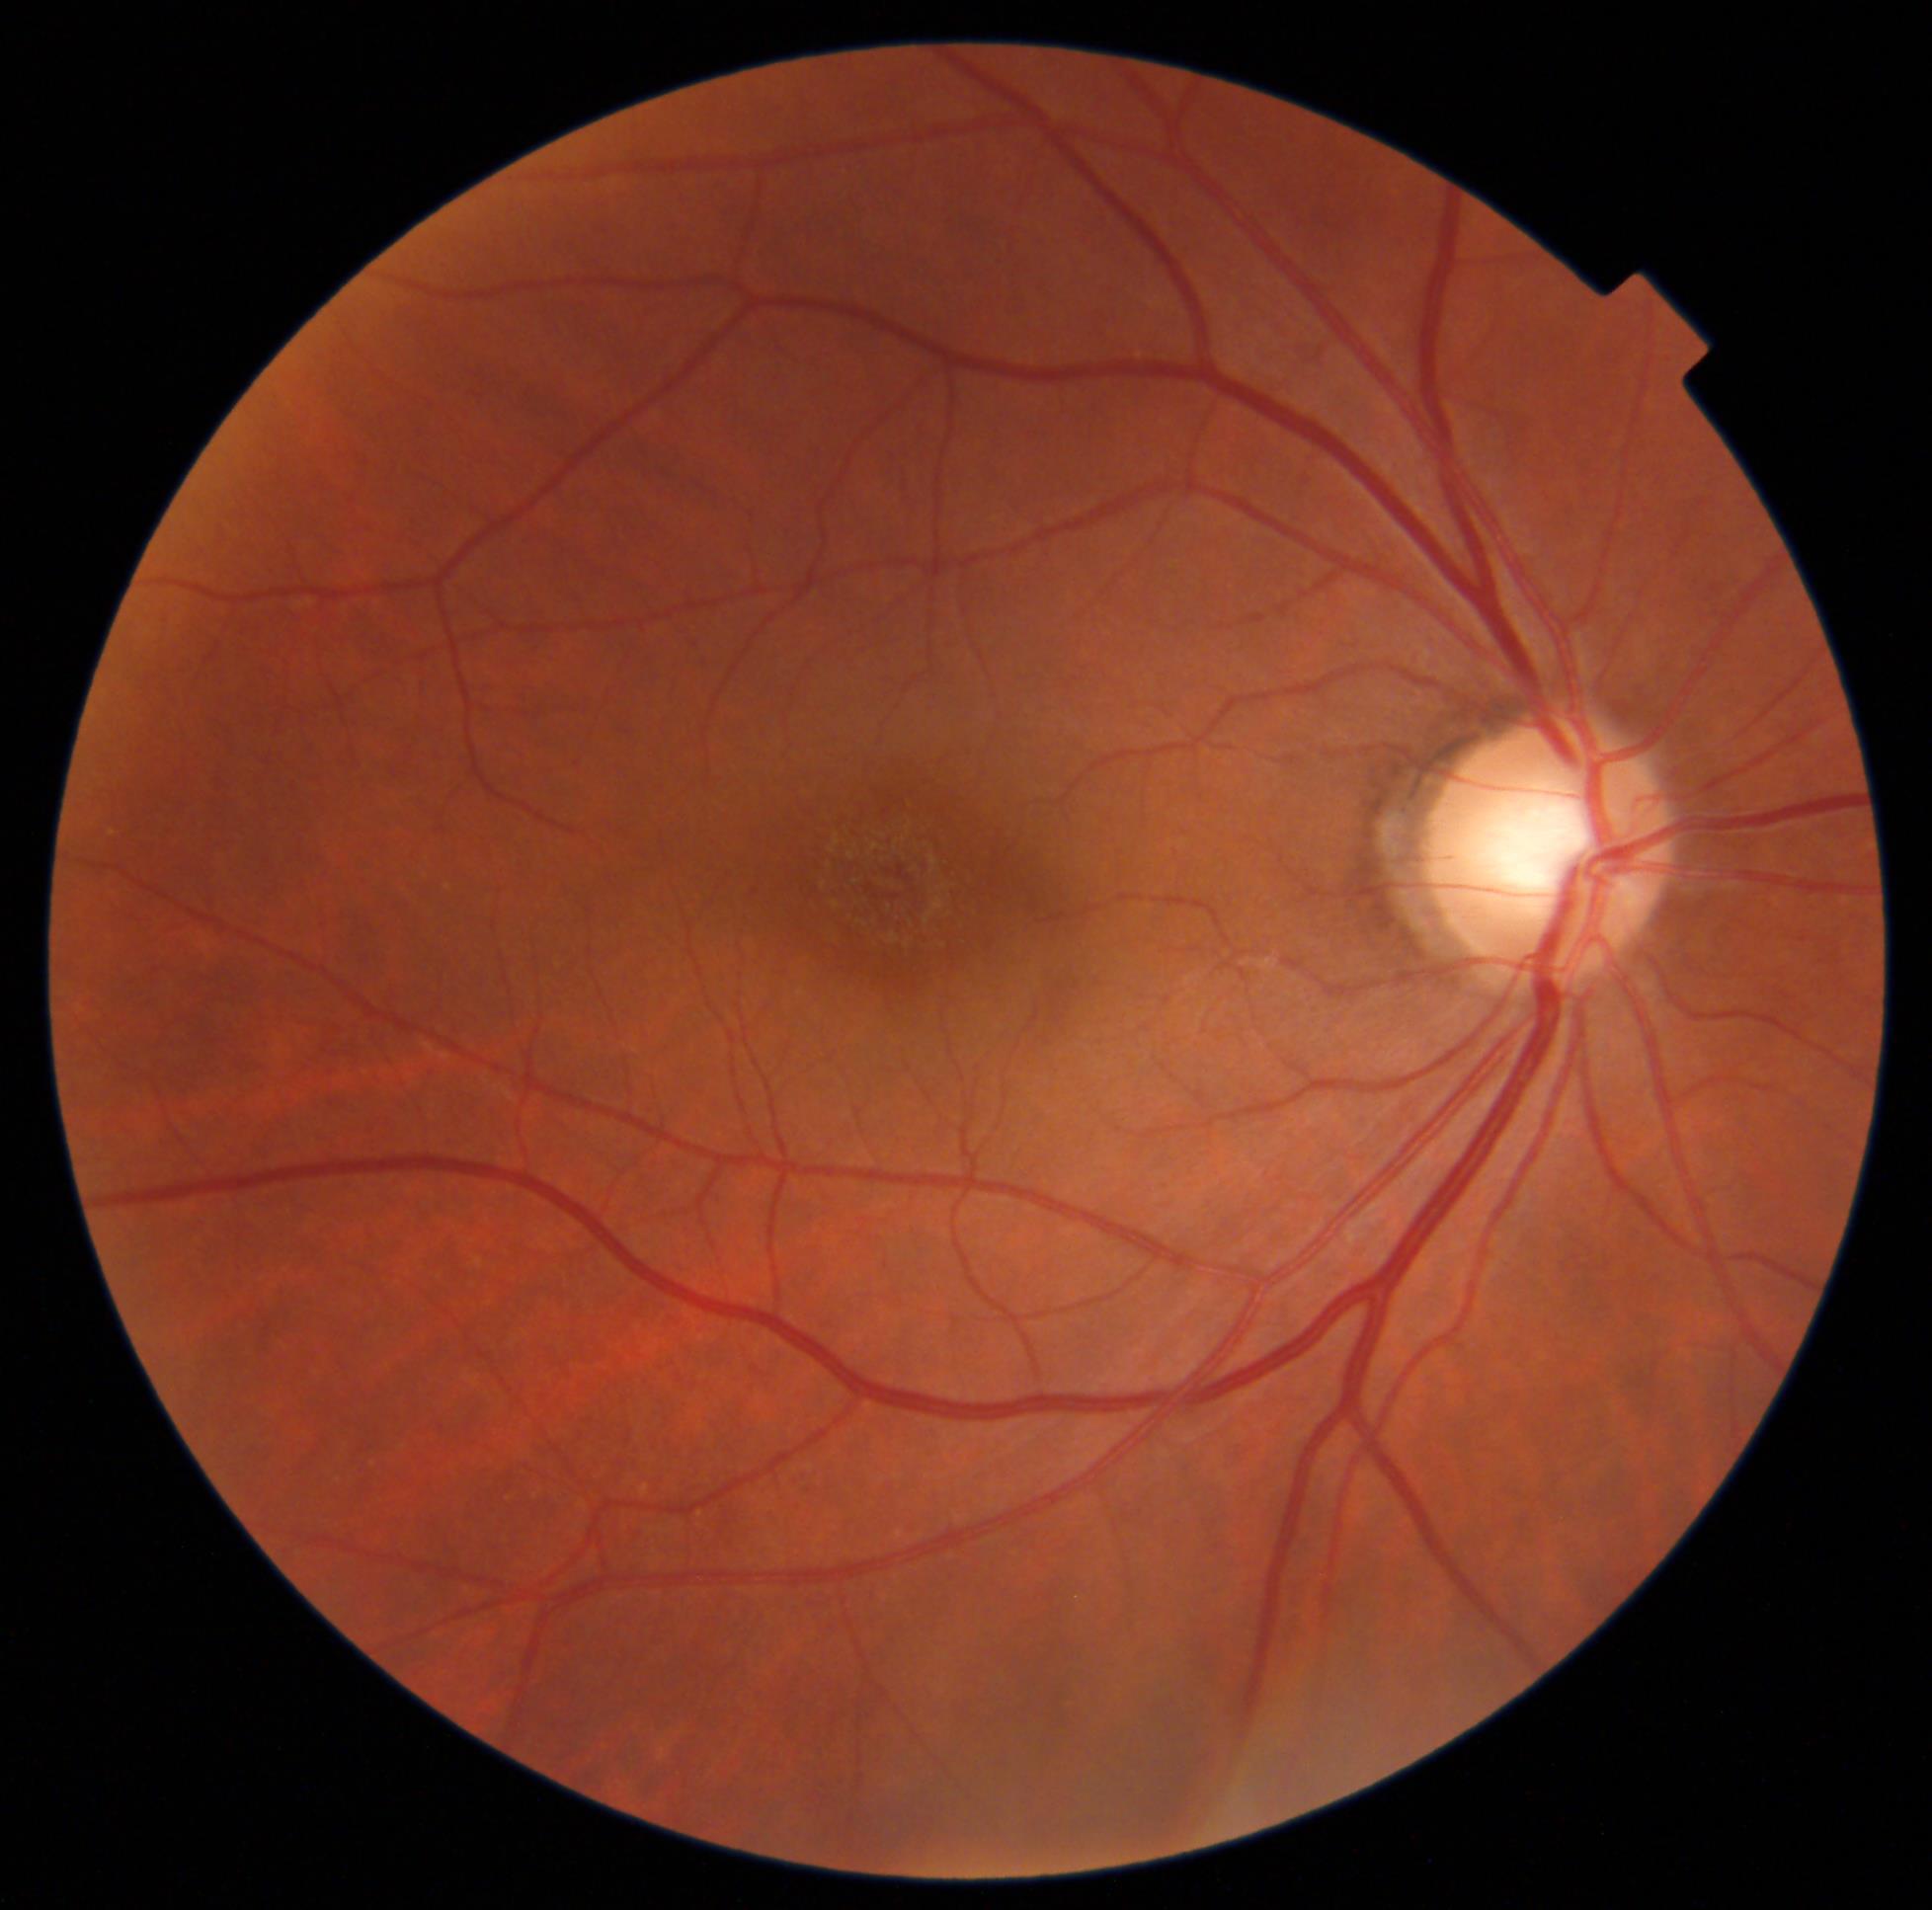
DR grade: 0 (no apparent retinopathy).
No diabetic retinal disease findings.